FOV: 45 degrees. 2352x1568. CFP
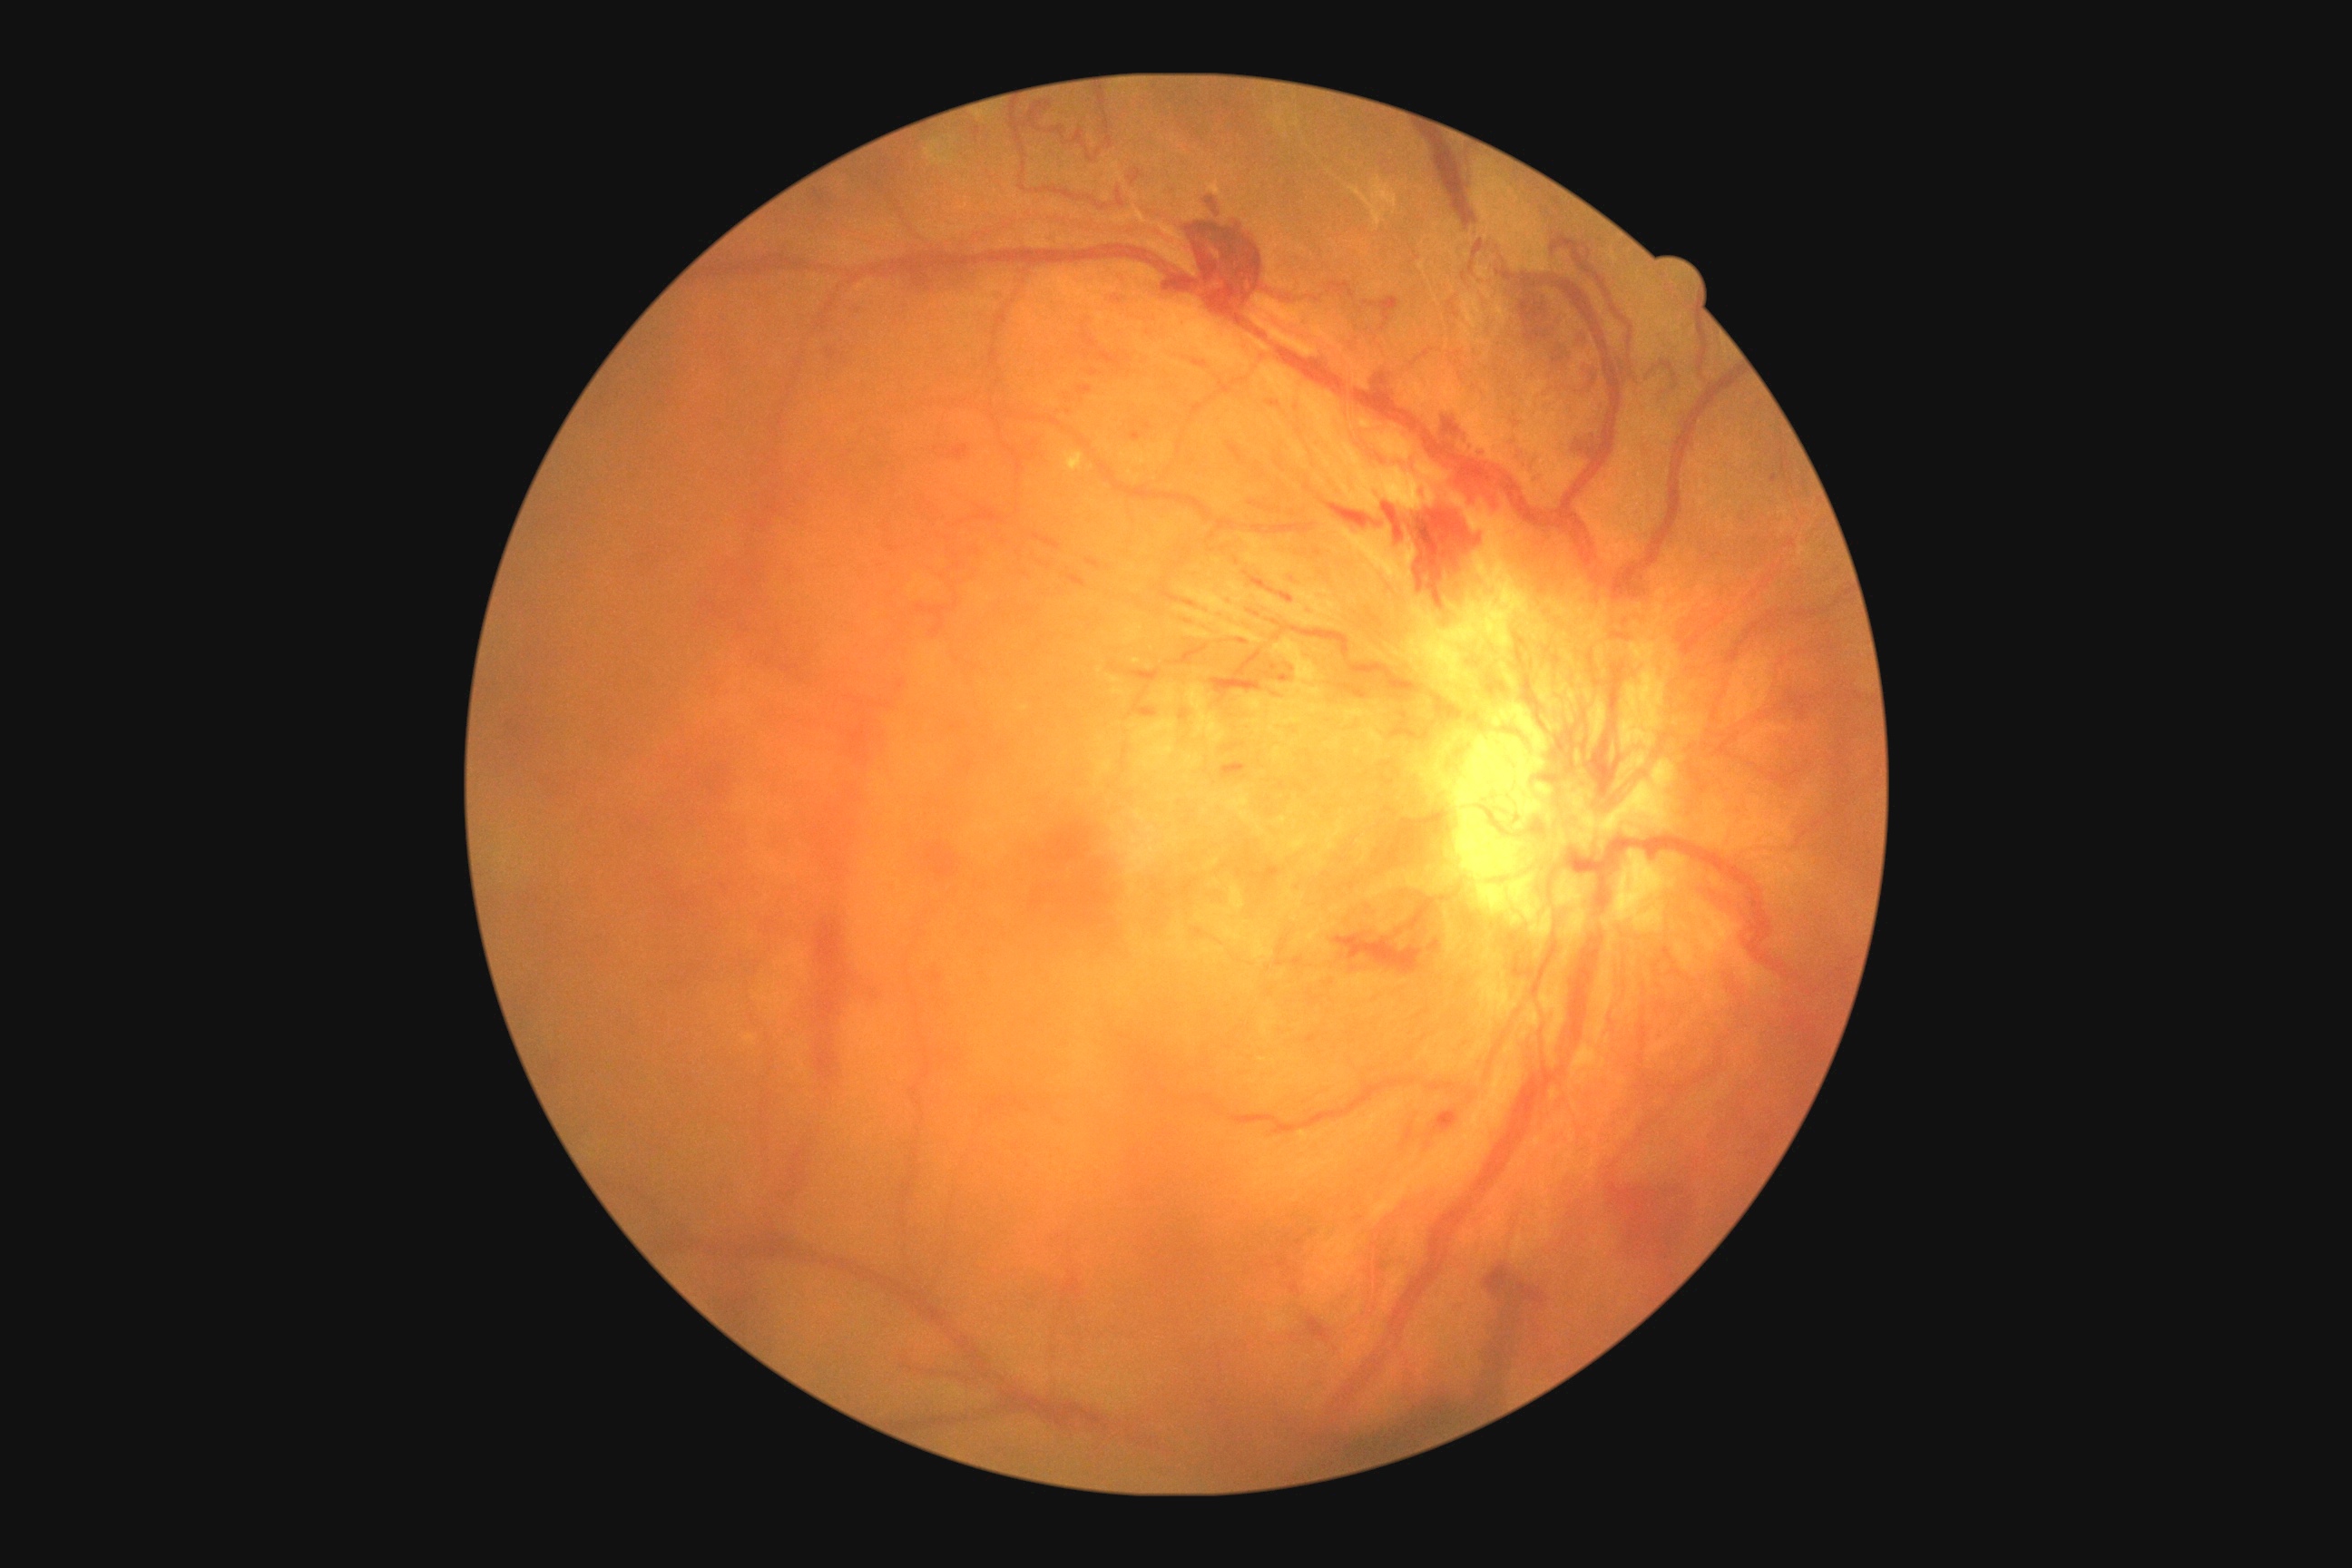
DR class@proliferative diabetic retinopathy; DR severity@grade 4 (PDR).